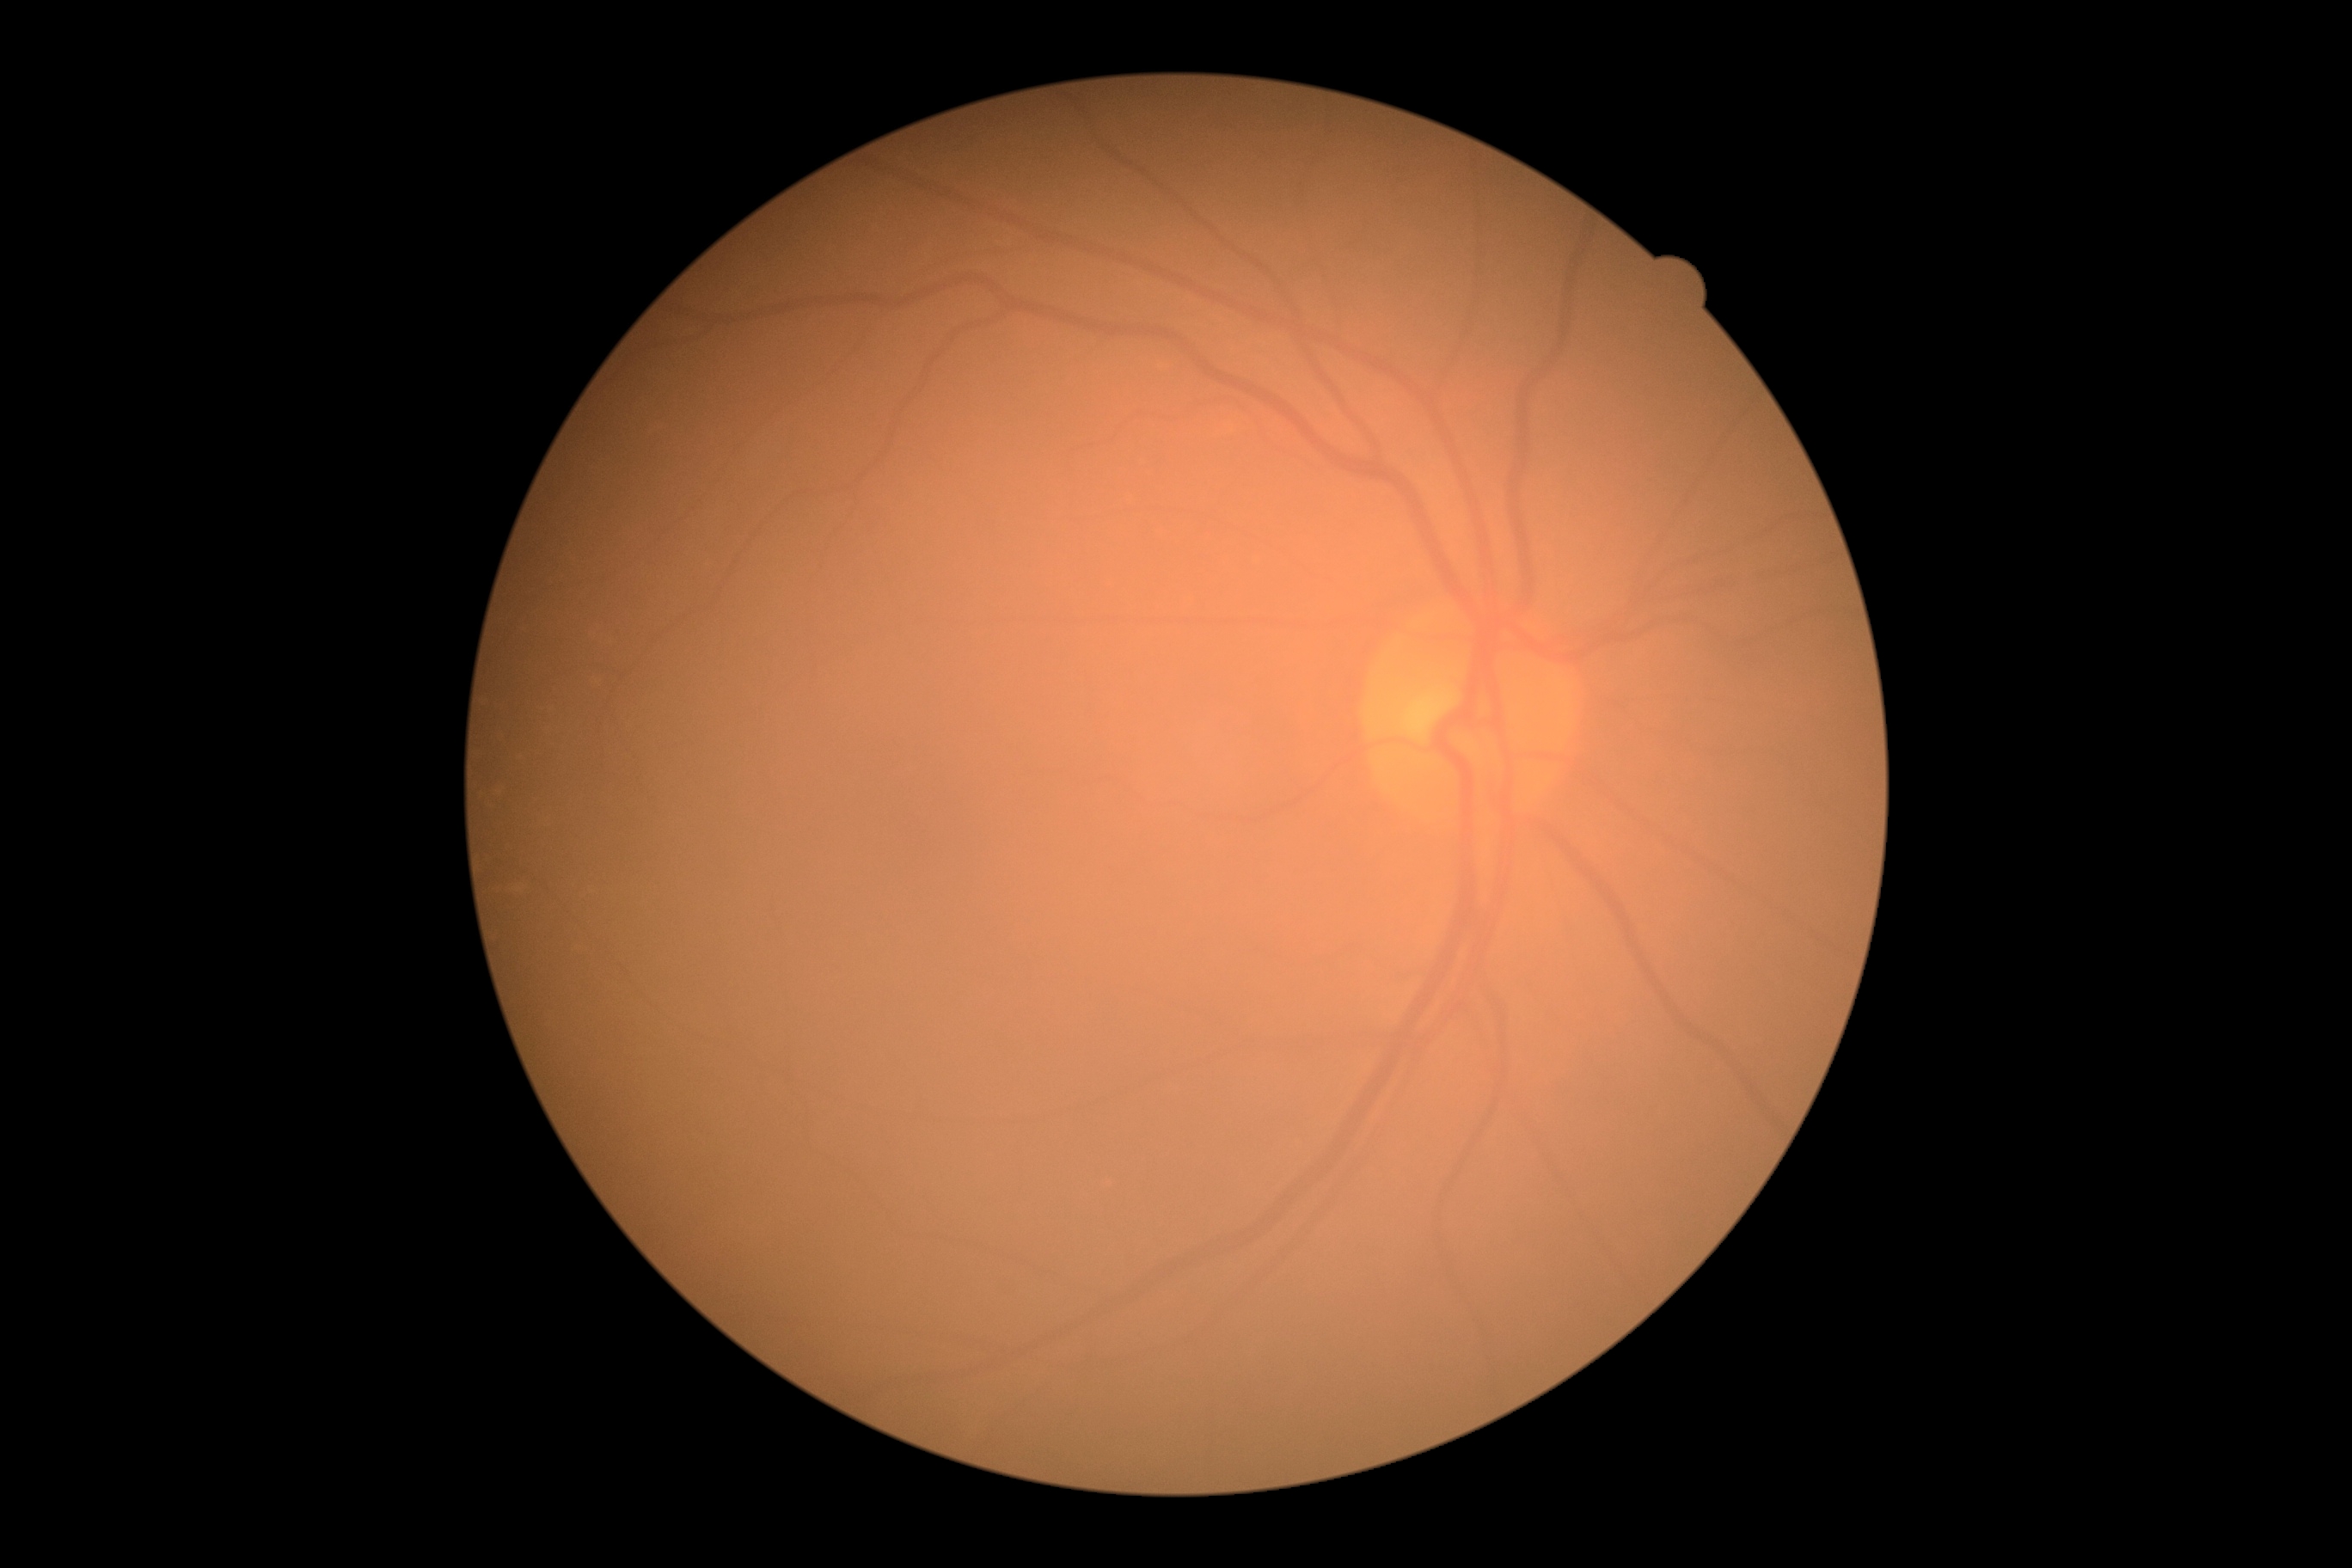 Diabetic retinopathy (DR): no apparent retinopathy (grade 0) — no visible signs of diabetic retinopathy.